Camera: NIDEK AFC-230: 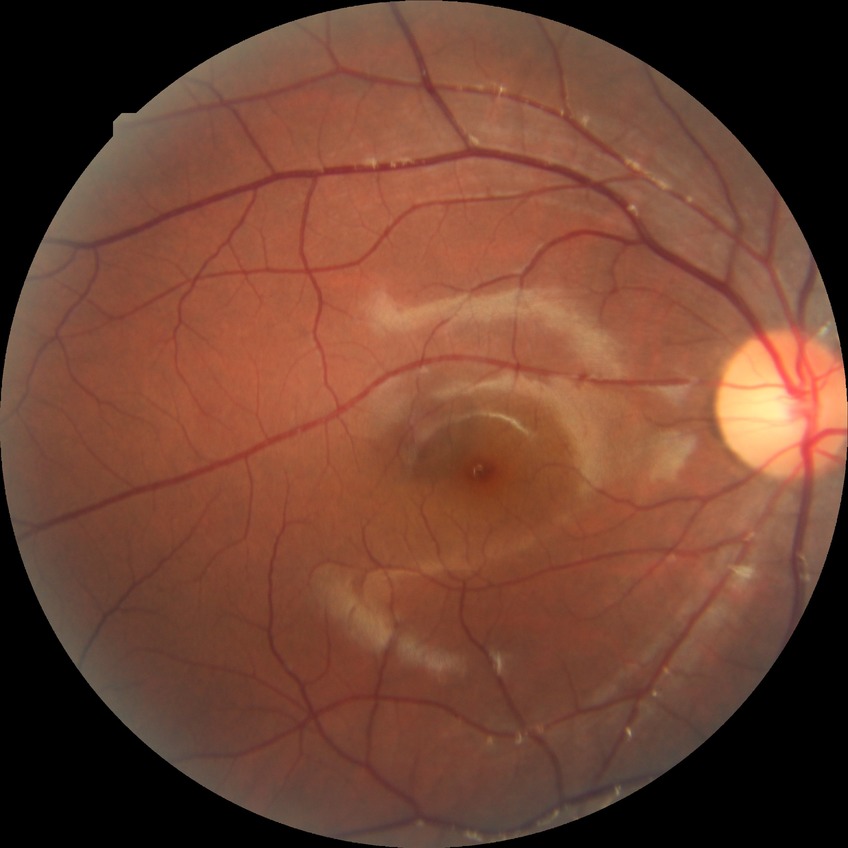

Davis grade: NDR.